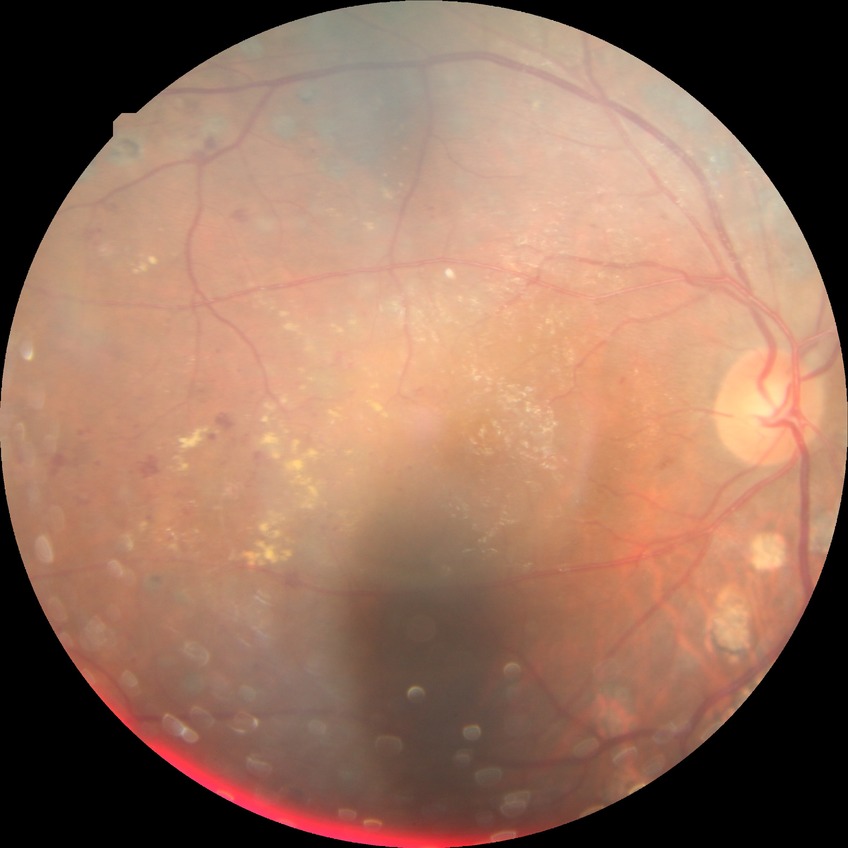 diabetic retinopathy (DR): proliferative diabetic retinopathy (PDR).